45-degree field of view
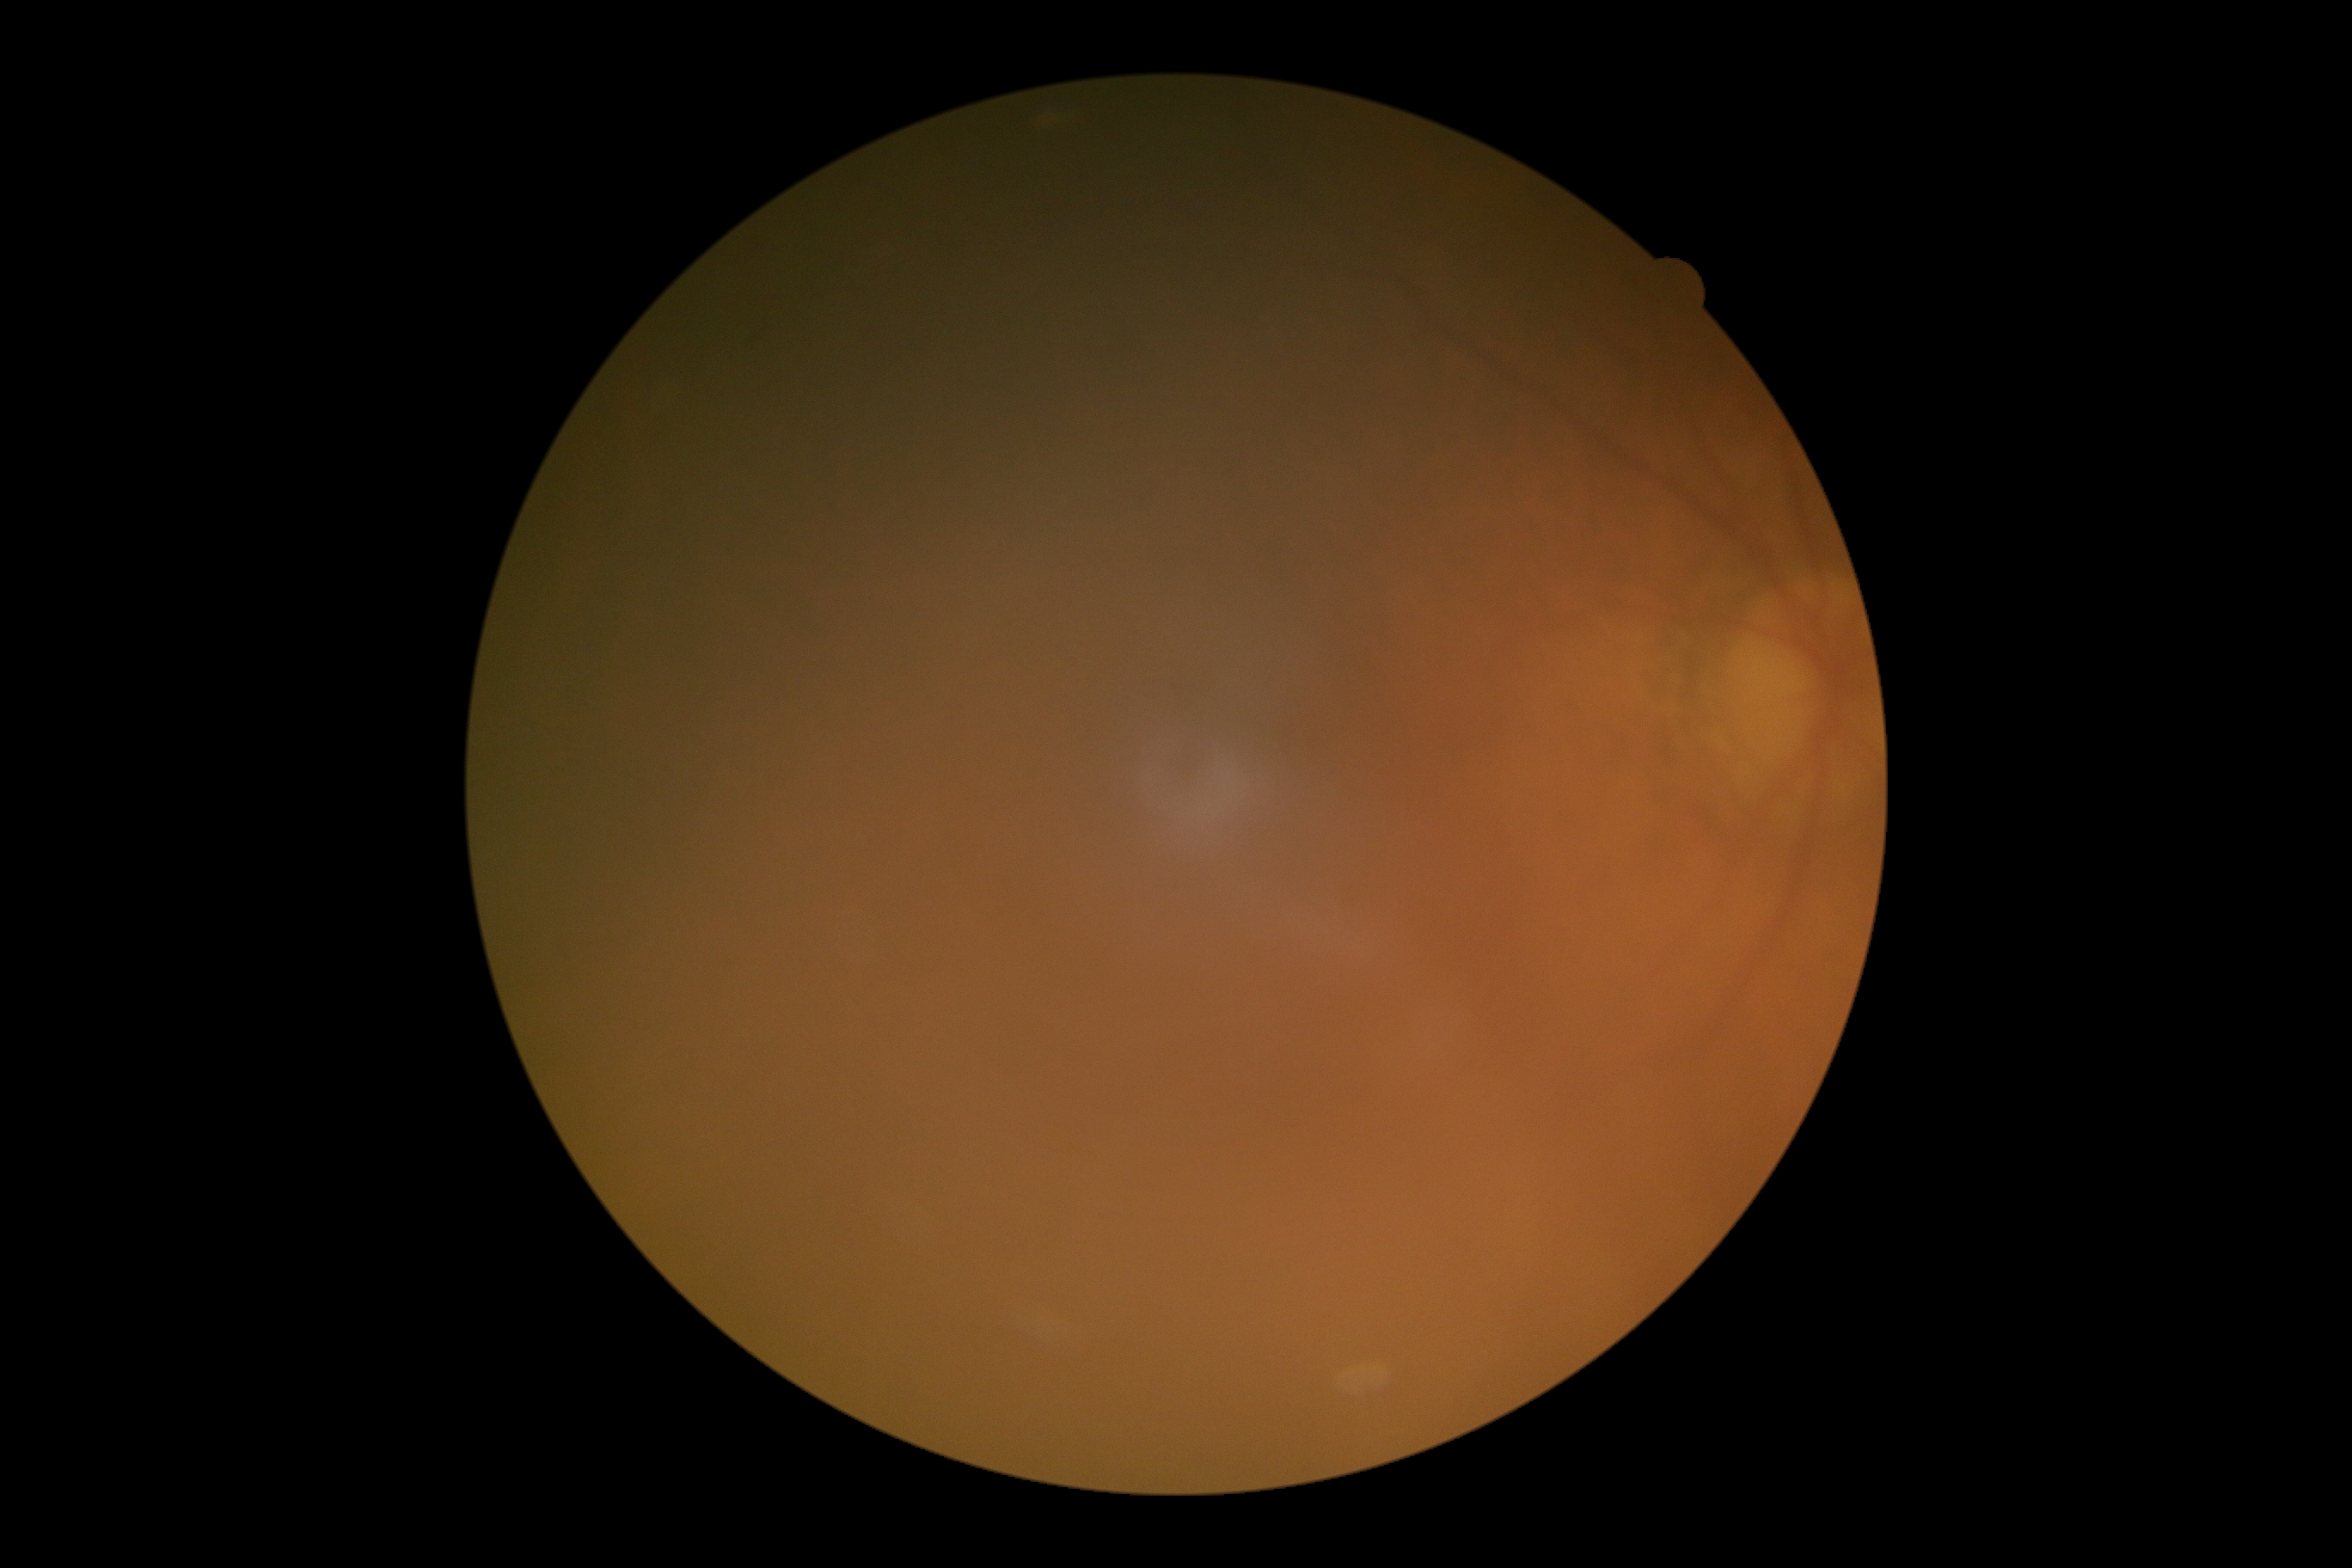

* retinopathy — ungradable due to poor image quality